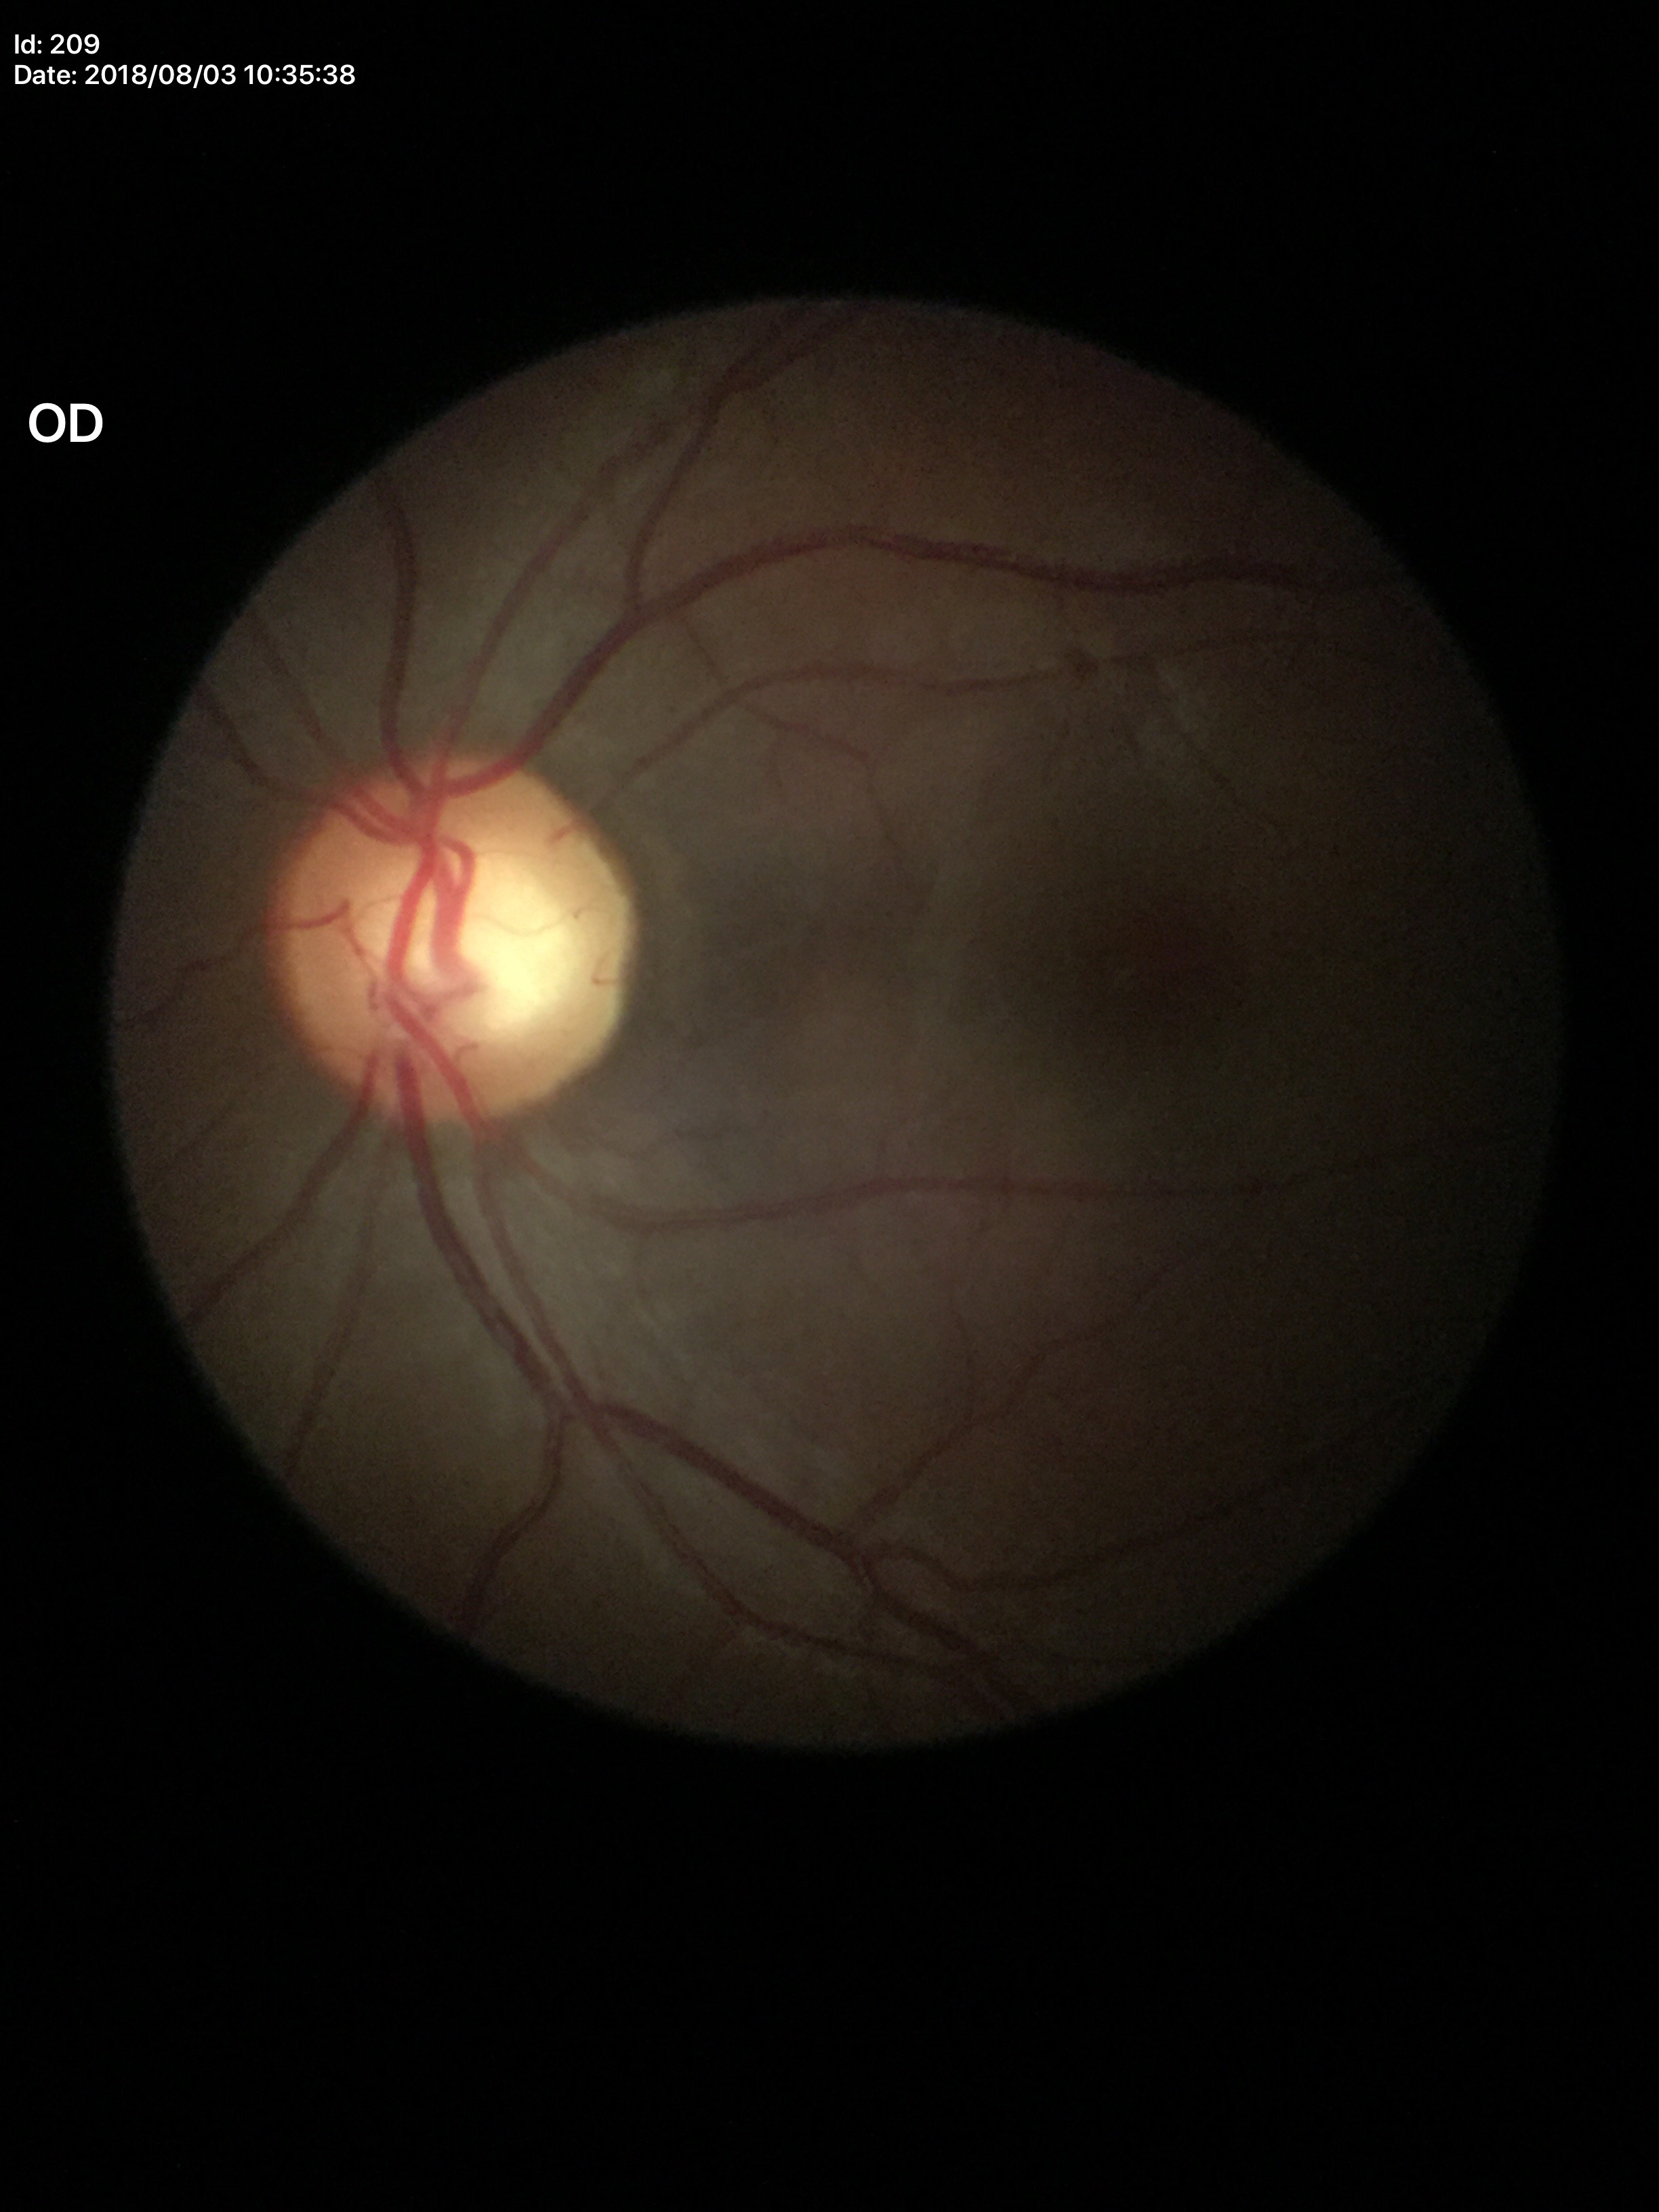 No evidence of glaucoma. Horizontal cup-disc ratio (HCDR) is 0.59. Vertical CDR (VCDR): 0.56.